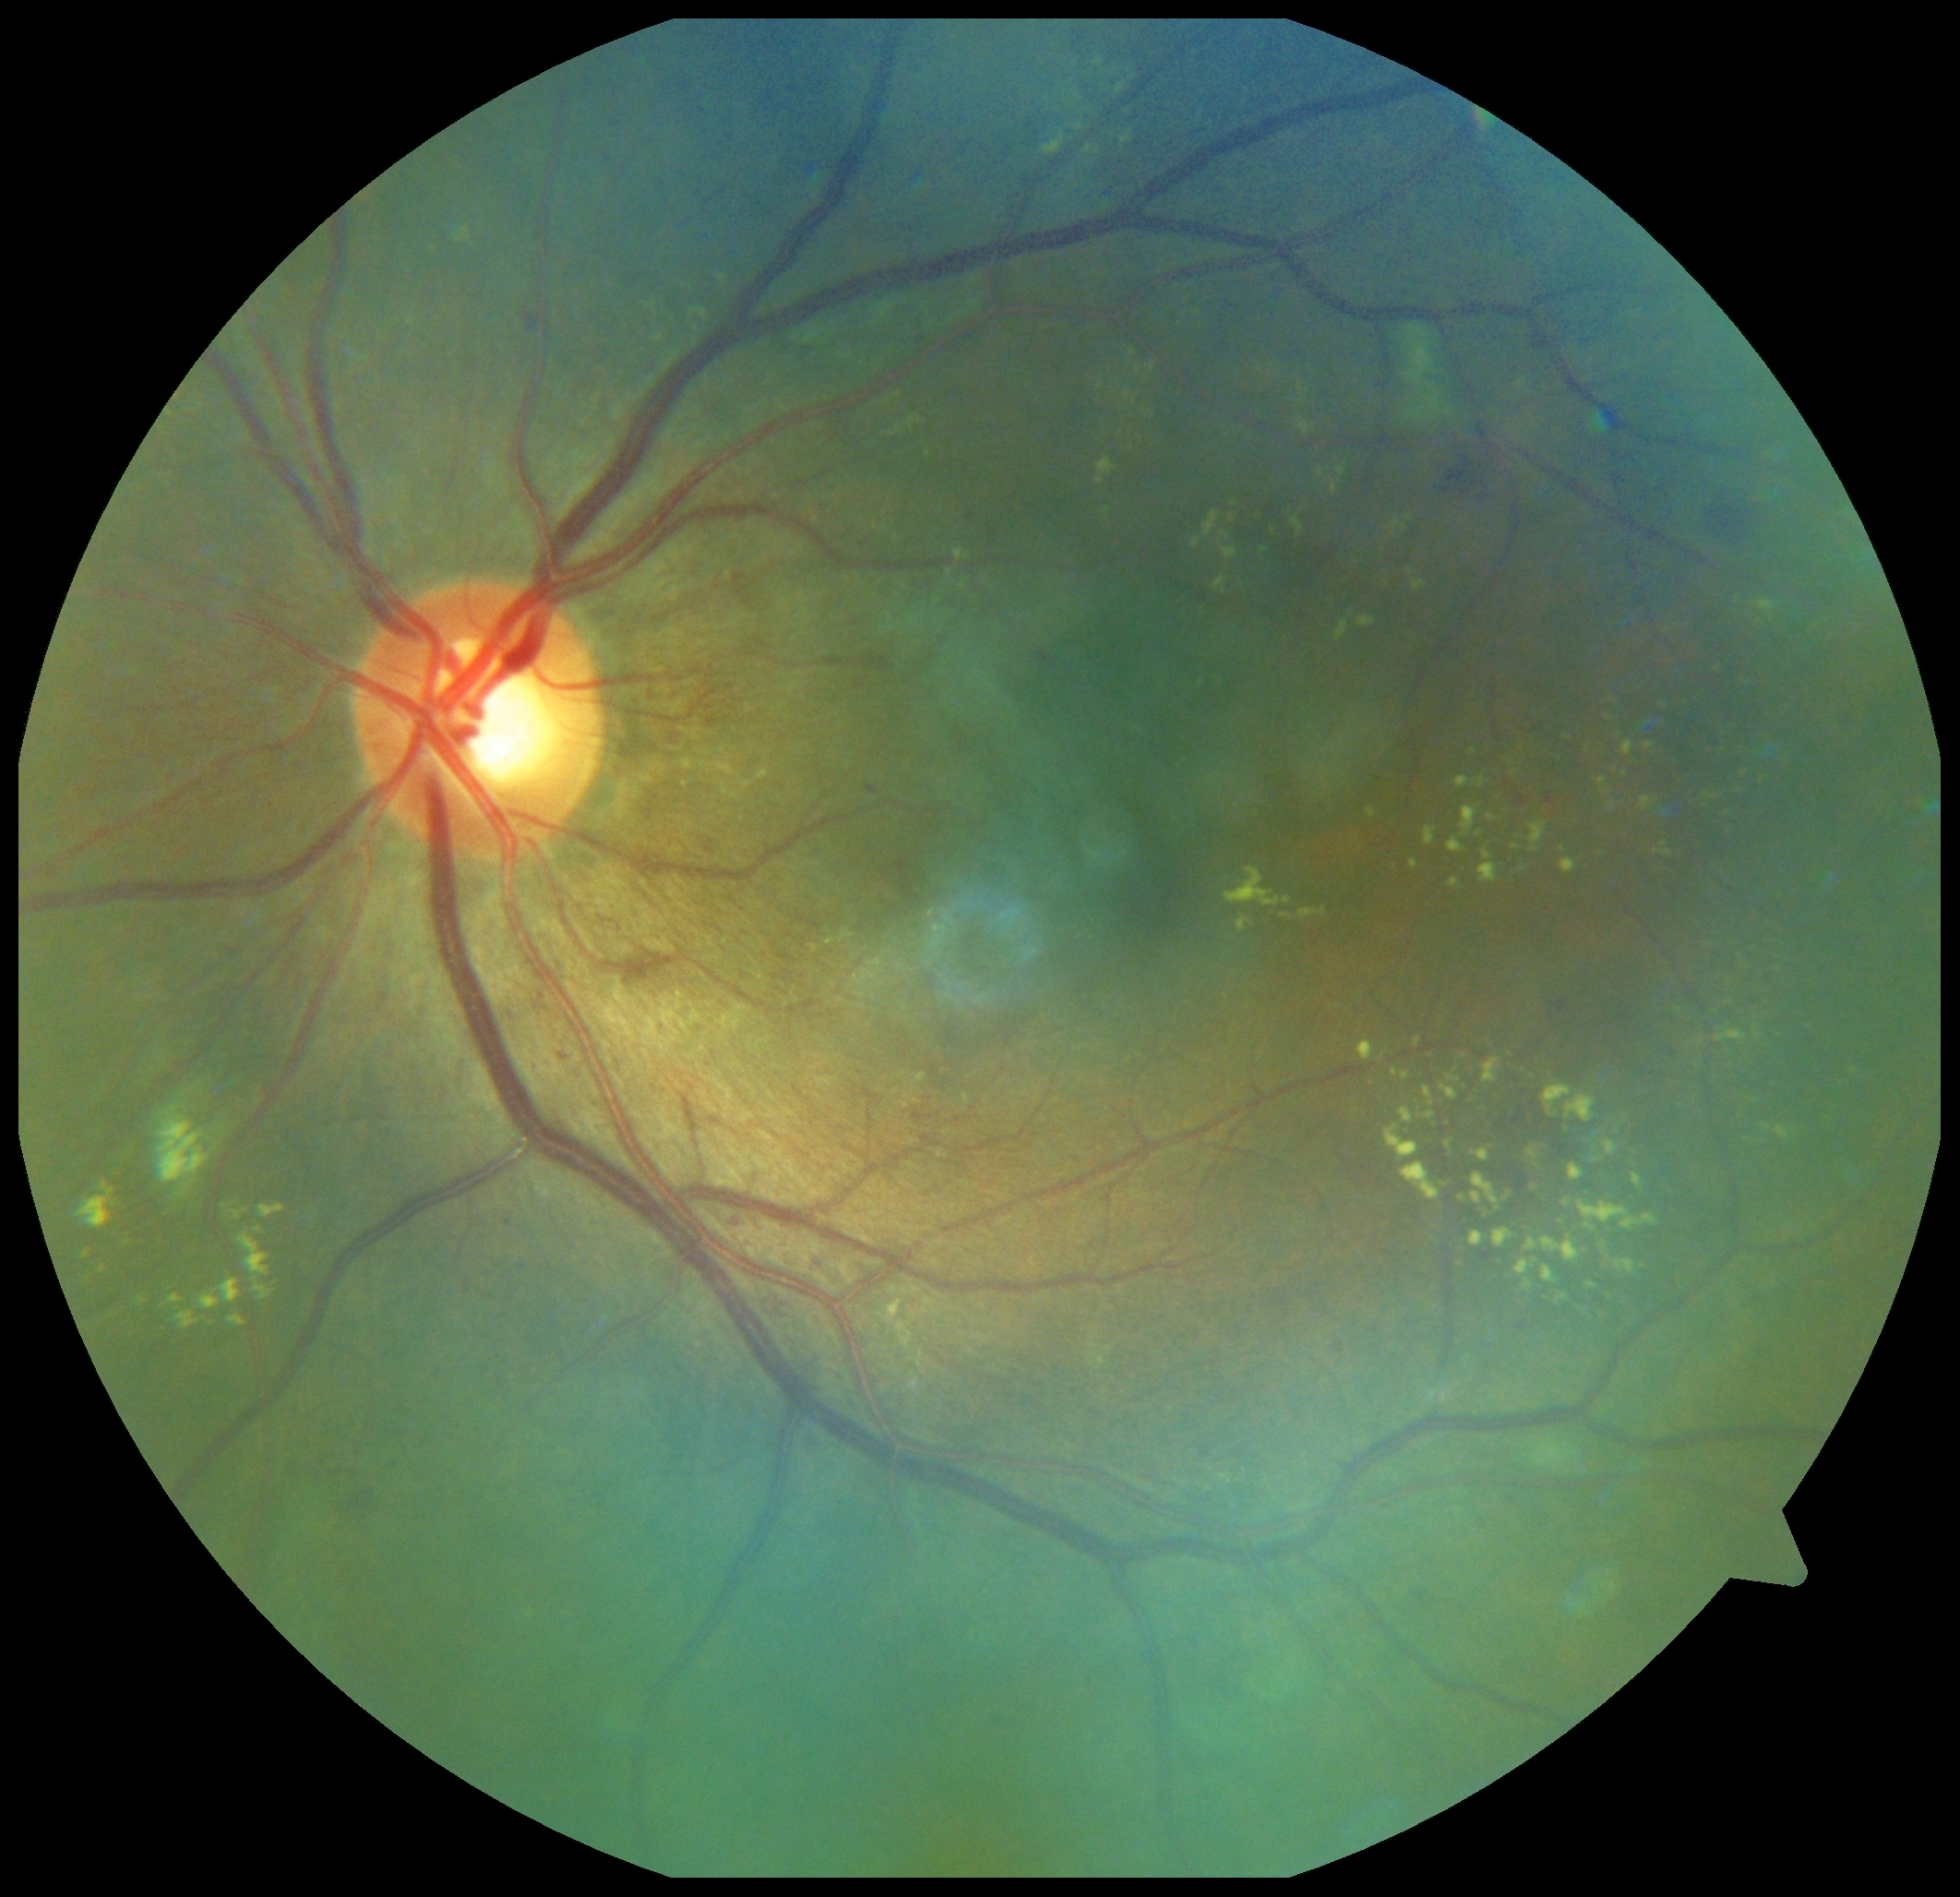

{"dr_grade": "moderate NPDR (grade 2)"}